2102 by 1736 pixels · color fundus photograph: 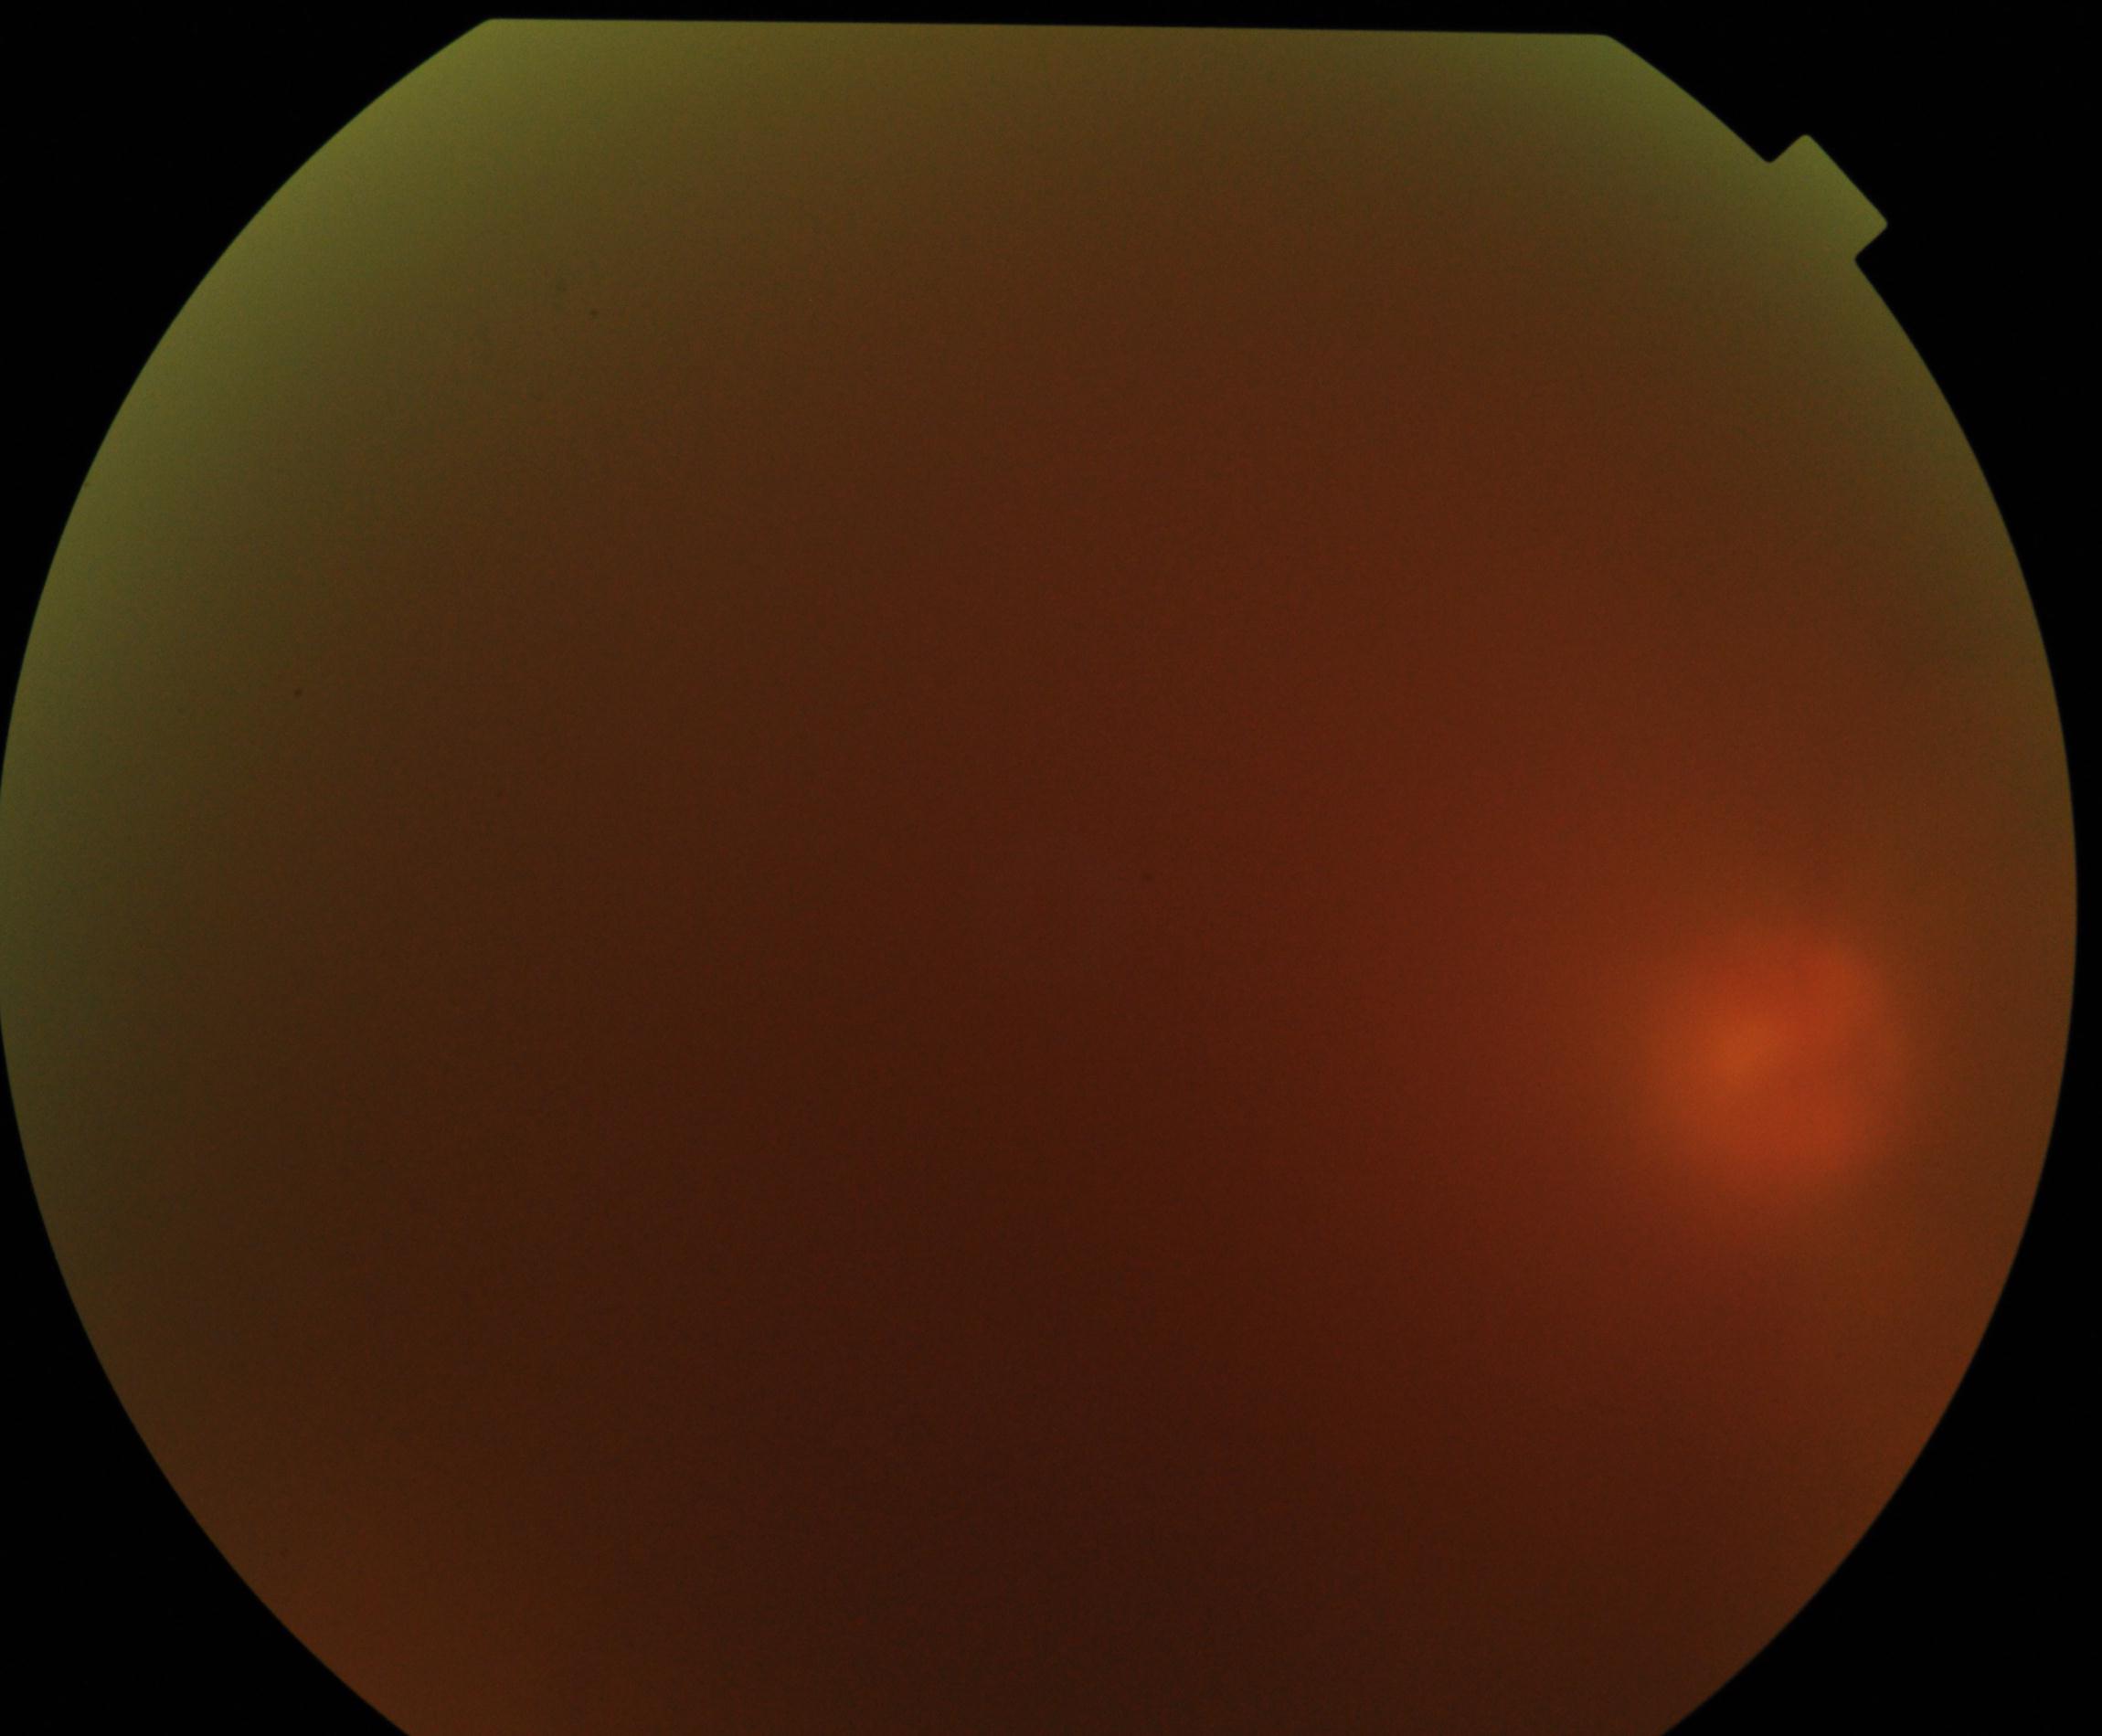
Image is blurred; retinal landmarks are largely obscured. No evidence of proliferative diabetic retinopathy.